848 by 848 pixels
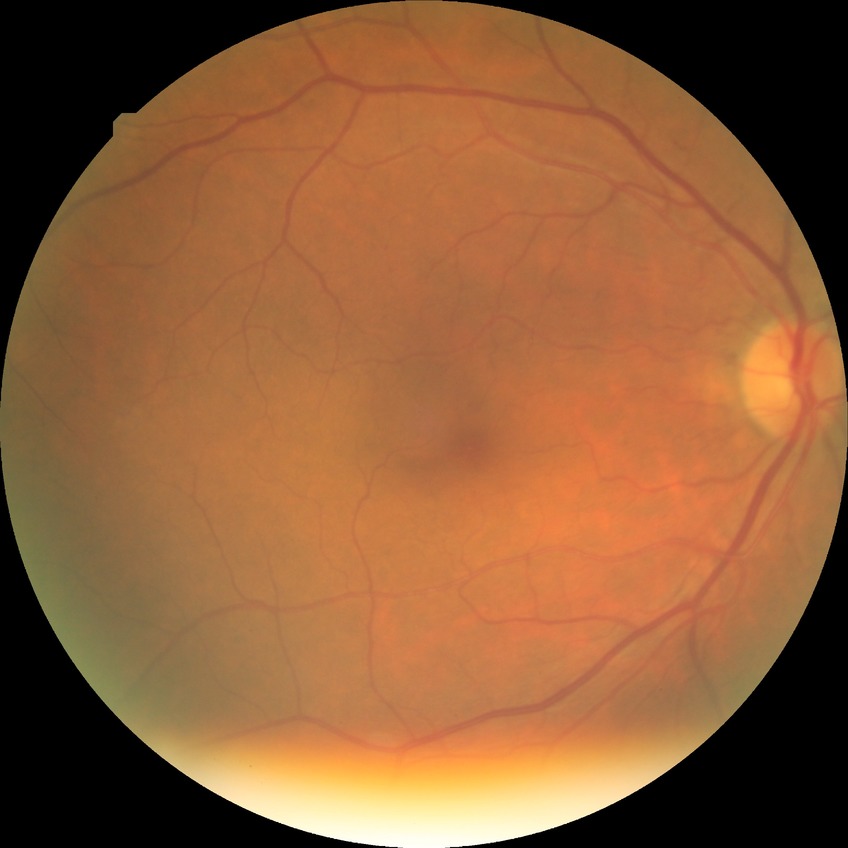 DR impression=no apparent DR, Davis grade=NDR.